Fundus photo. 2352x1568
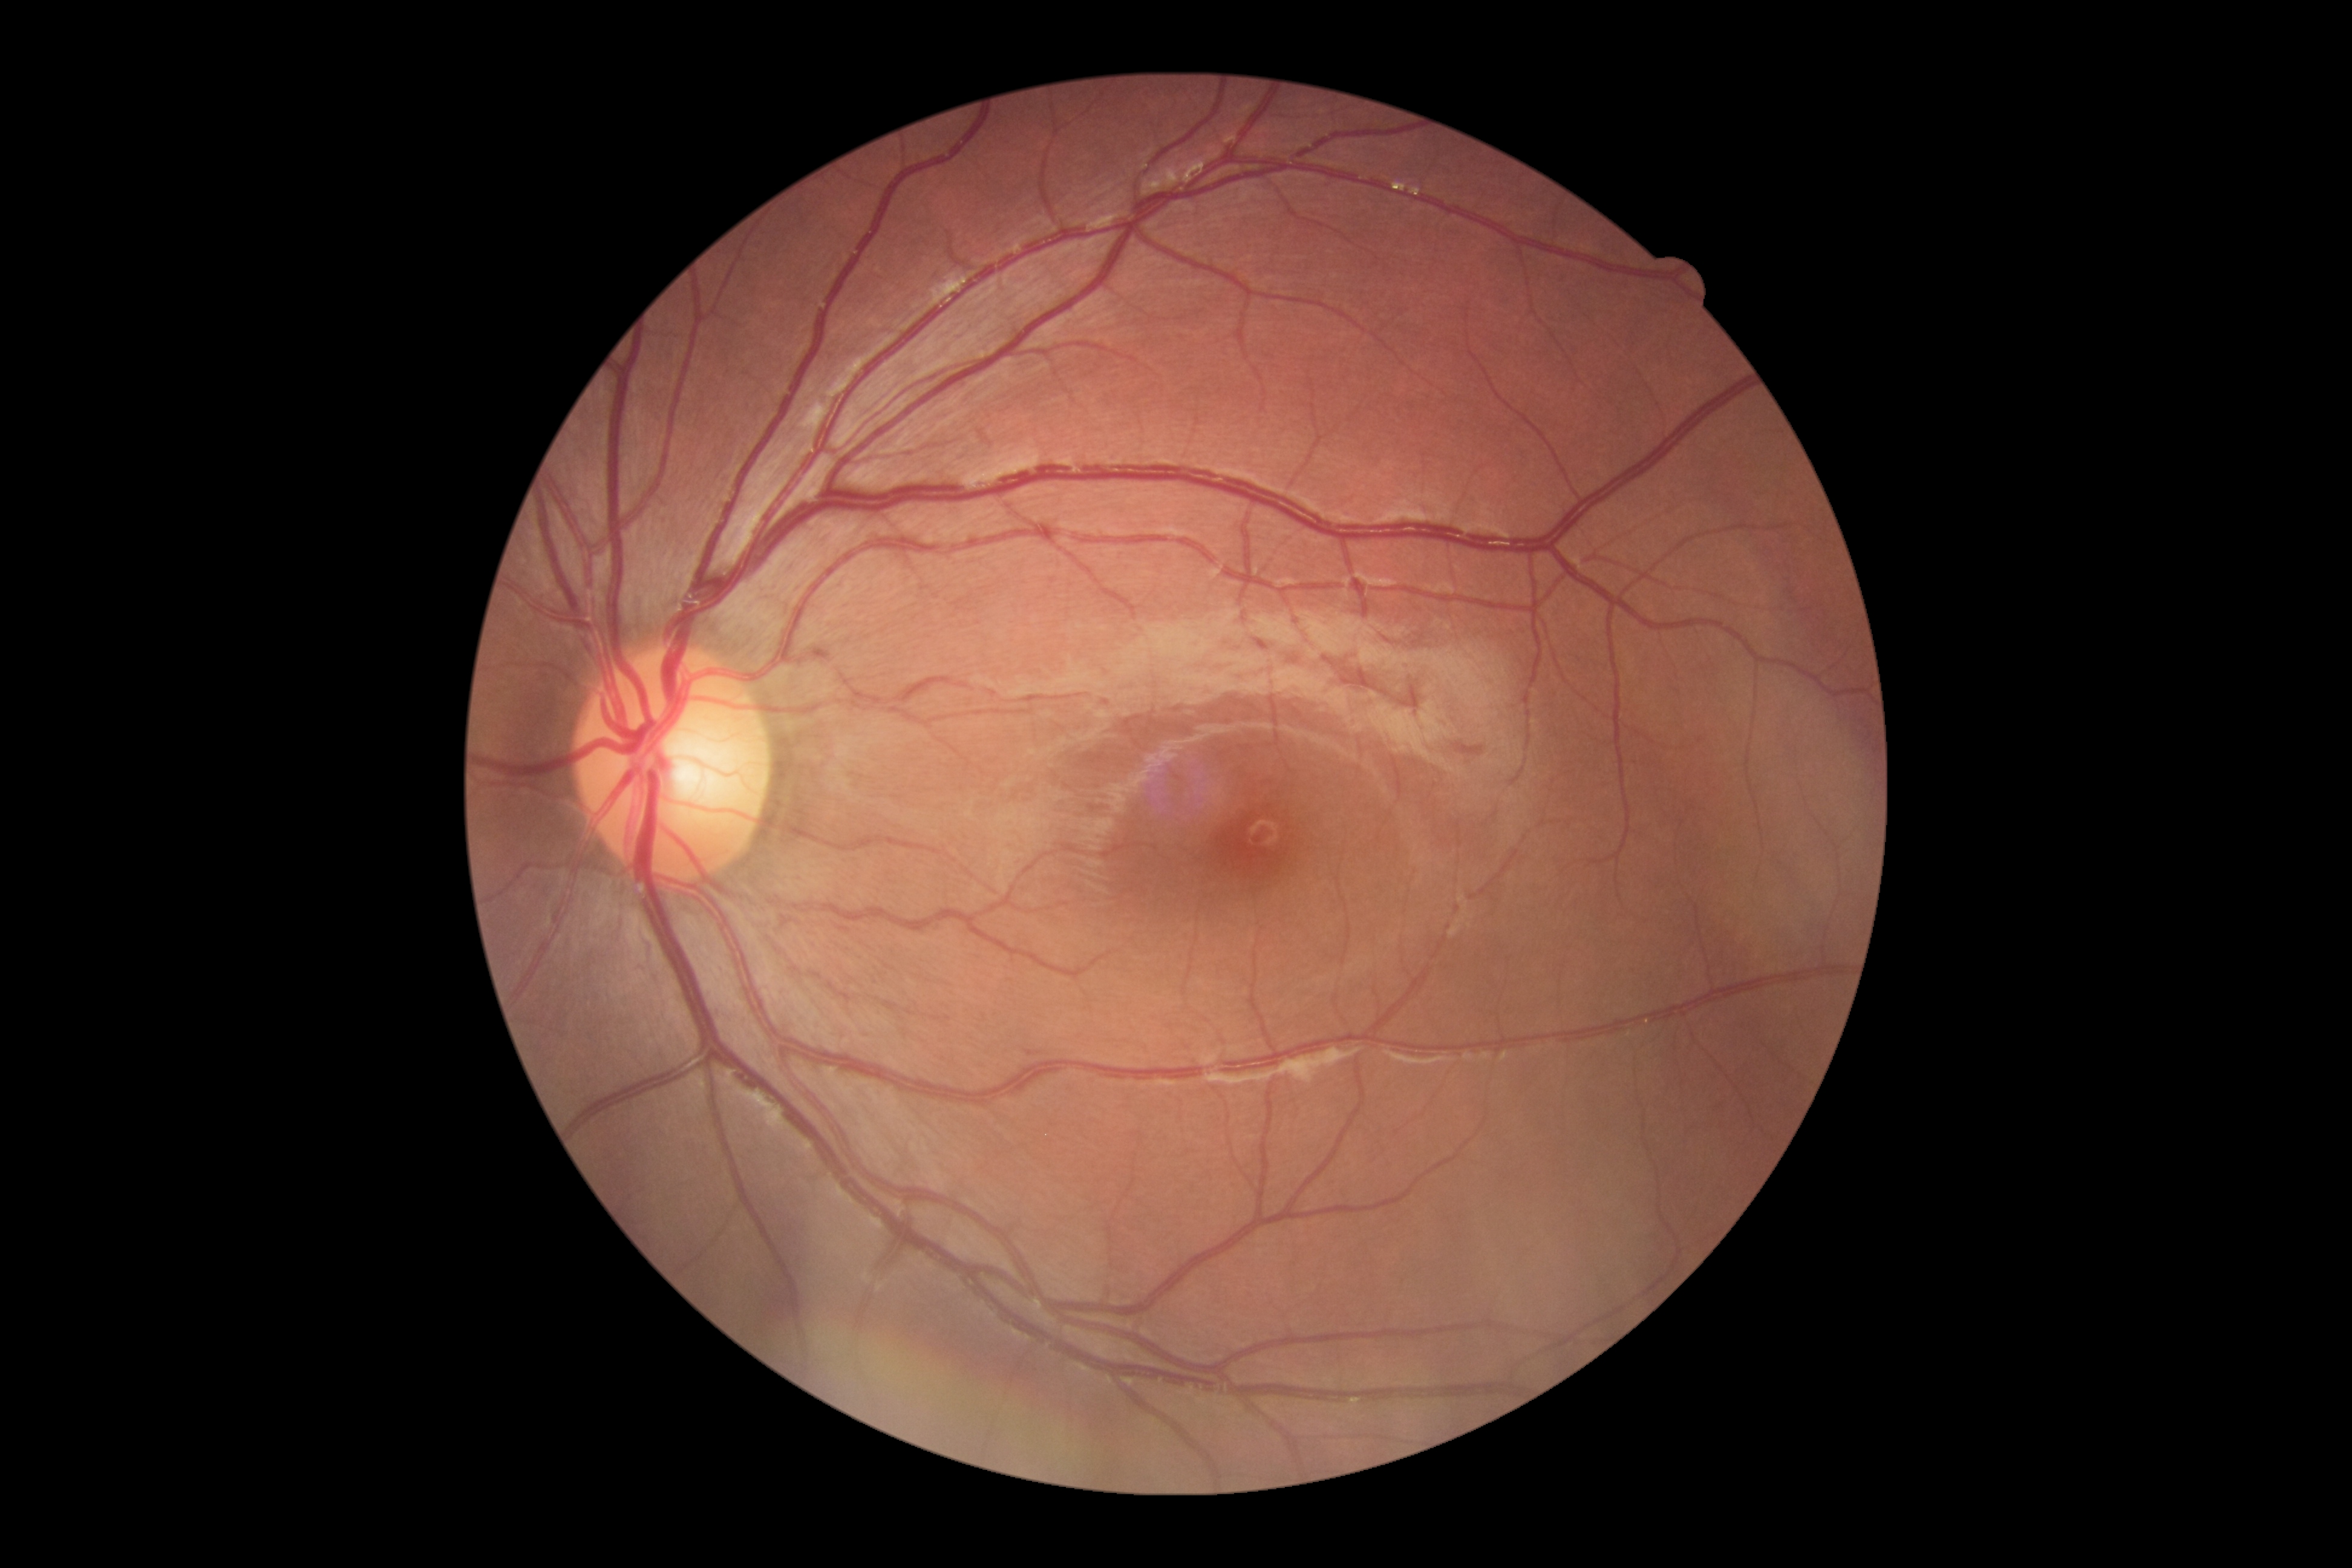

DR grade is no apparent retinopathy (0).